2352x1568:
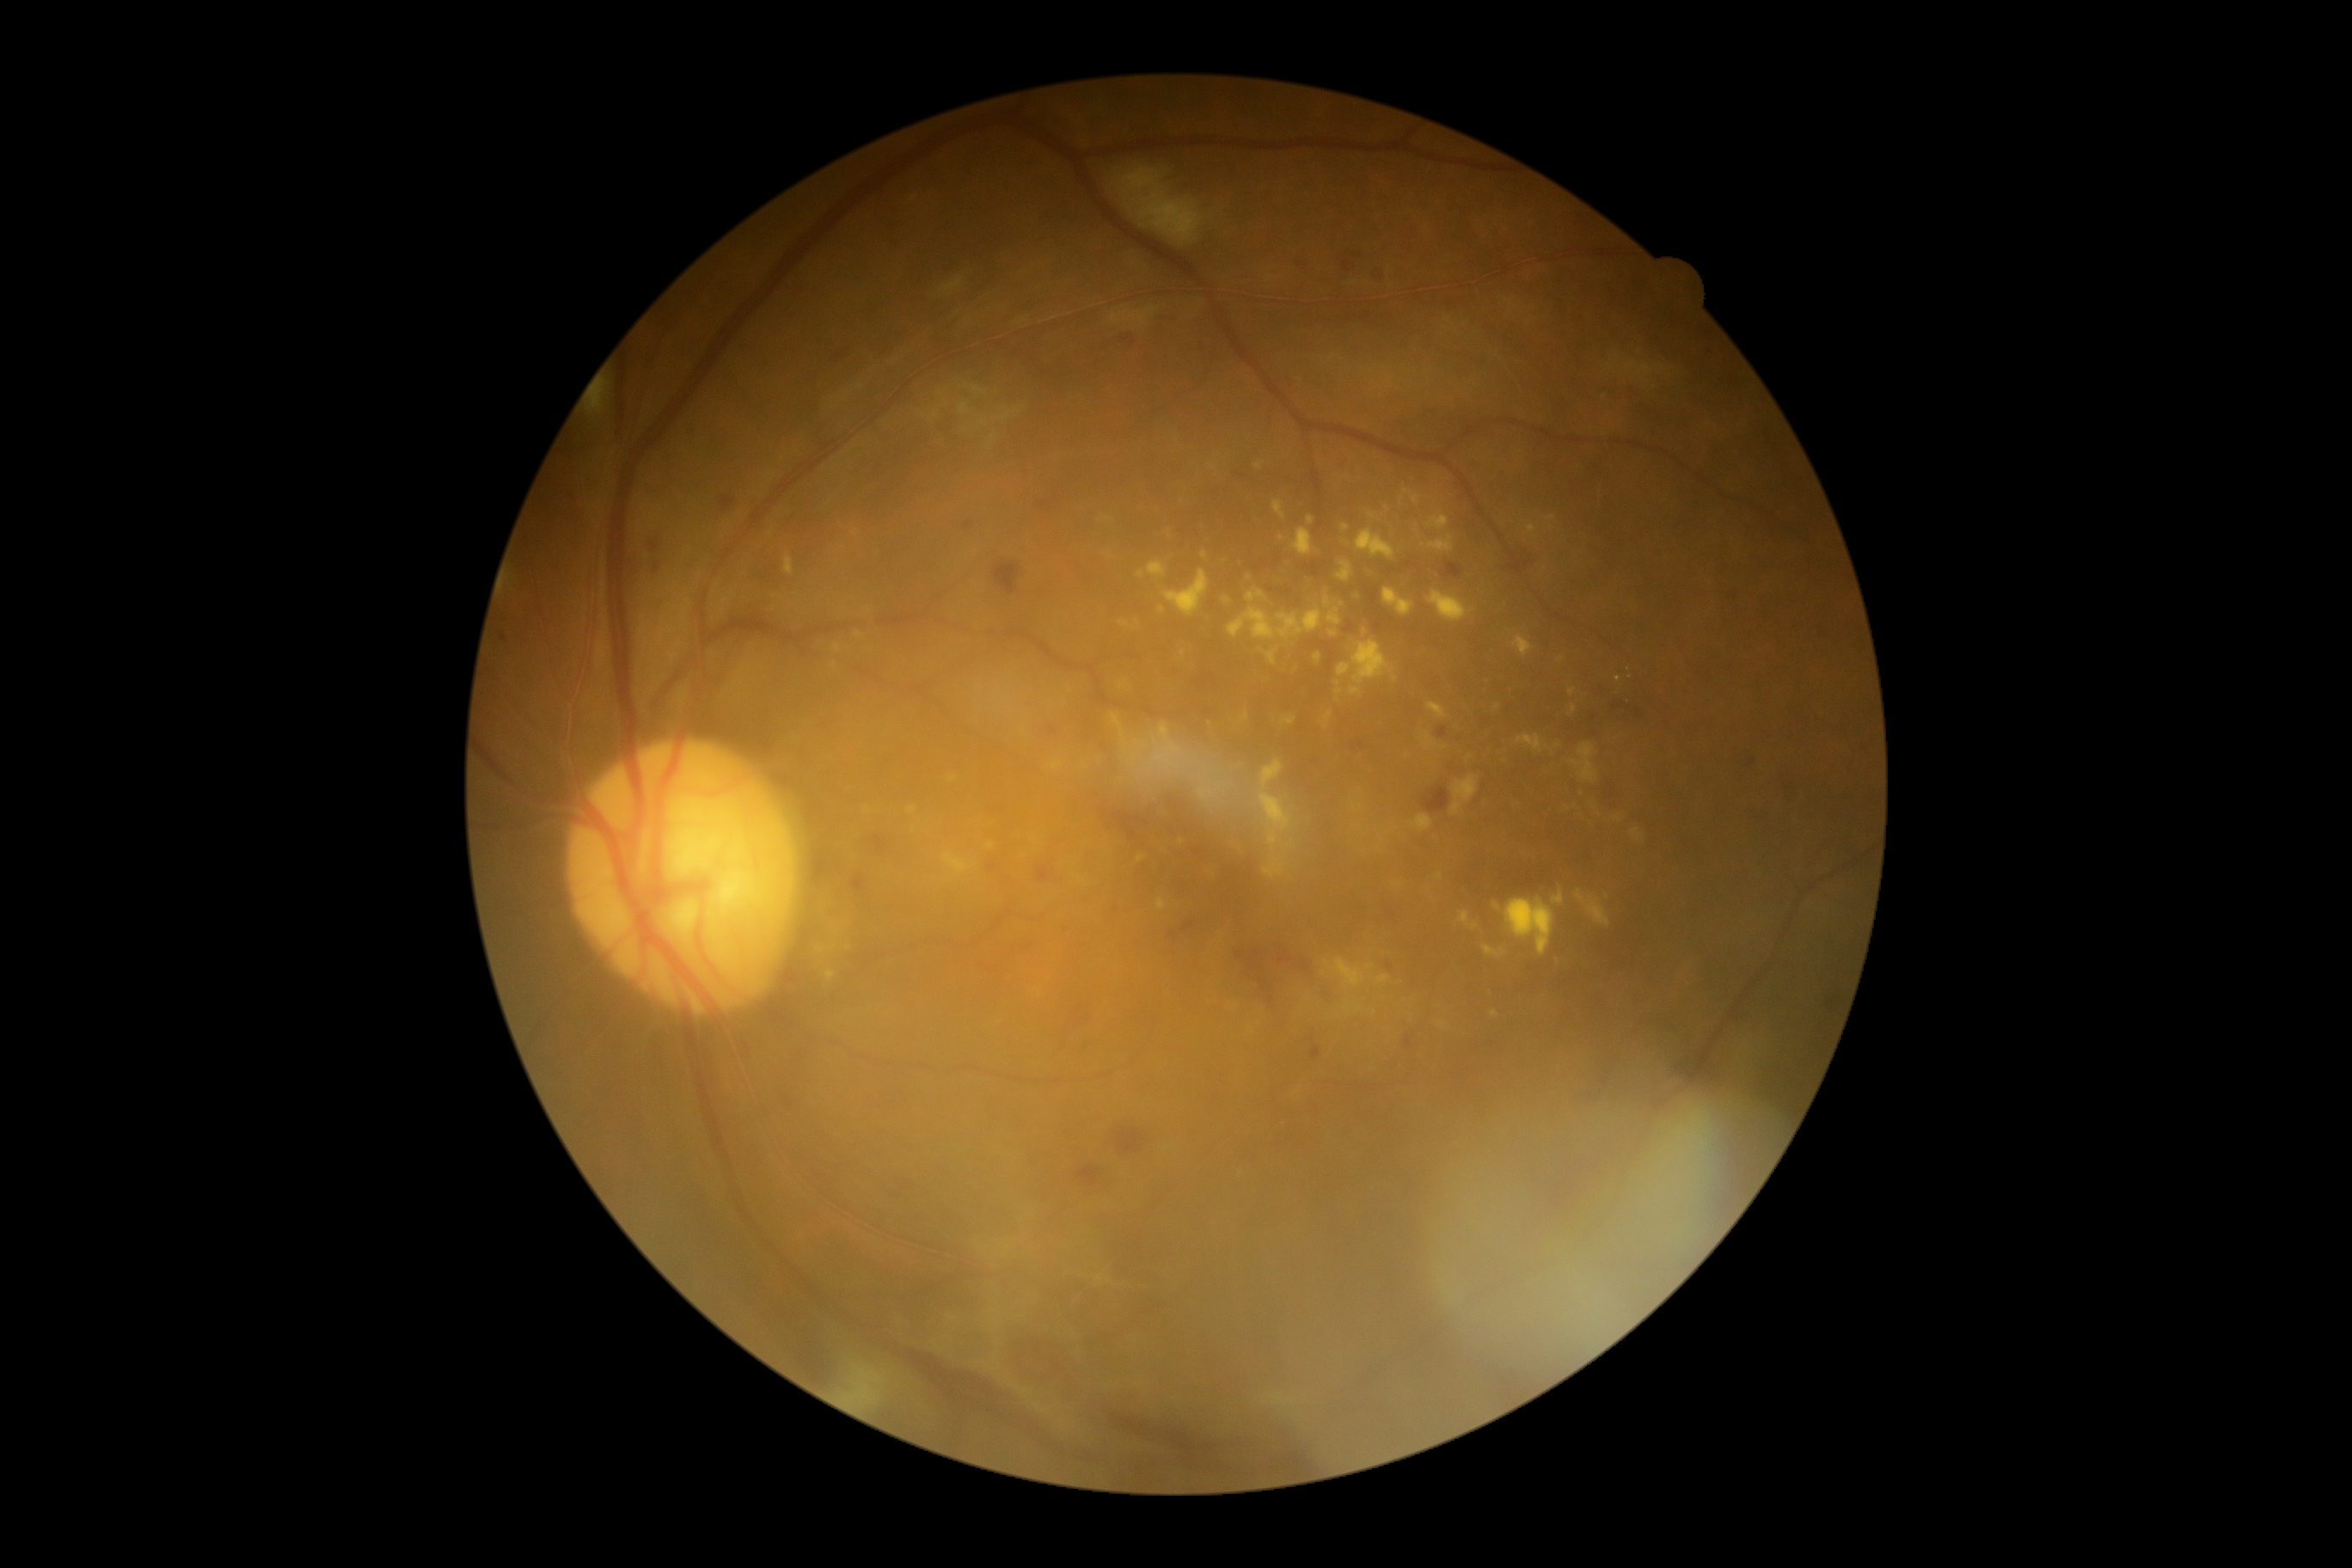
dr_grade: grade 2 (moderate NPDR) — more than just microaneurysms but less than severe NPDR
dr_category: non-proliferative diabetic retinopathy